Retinal fundus photograph
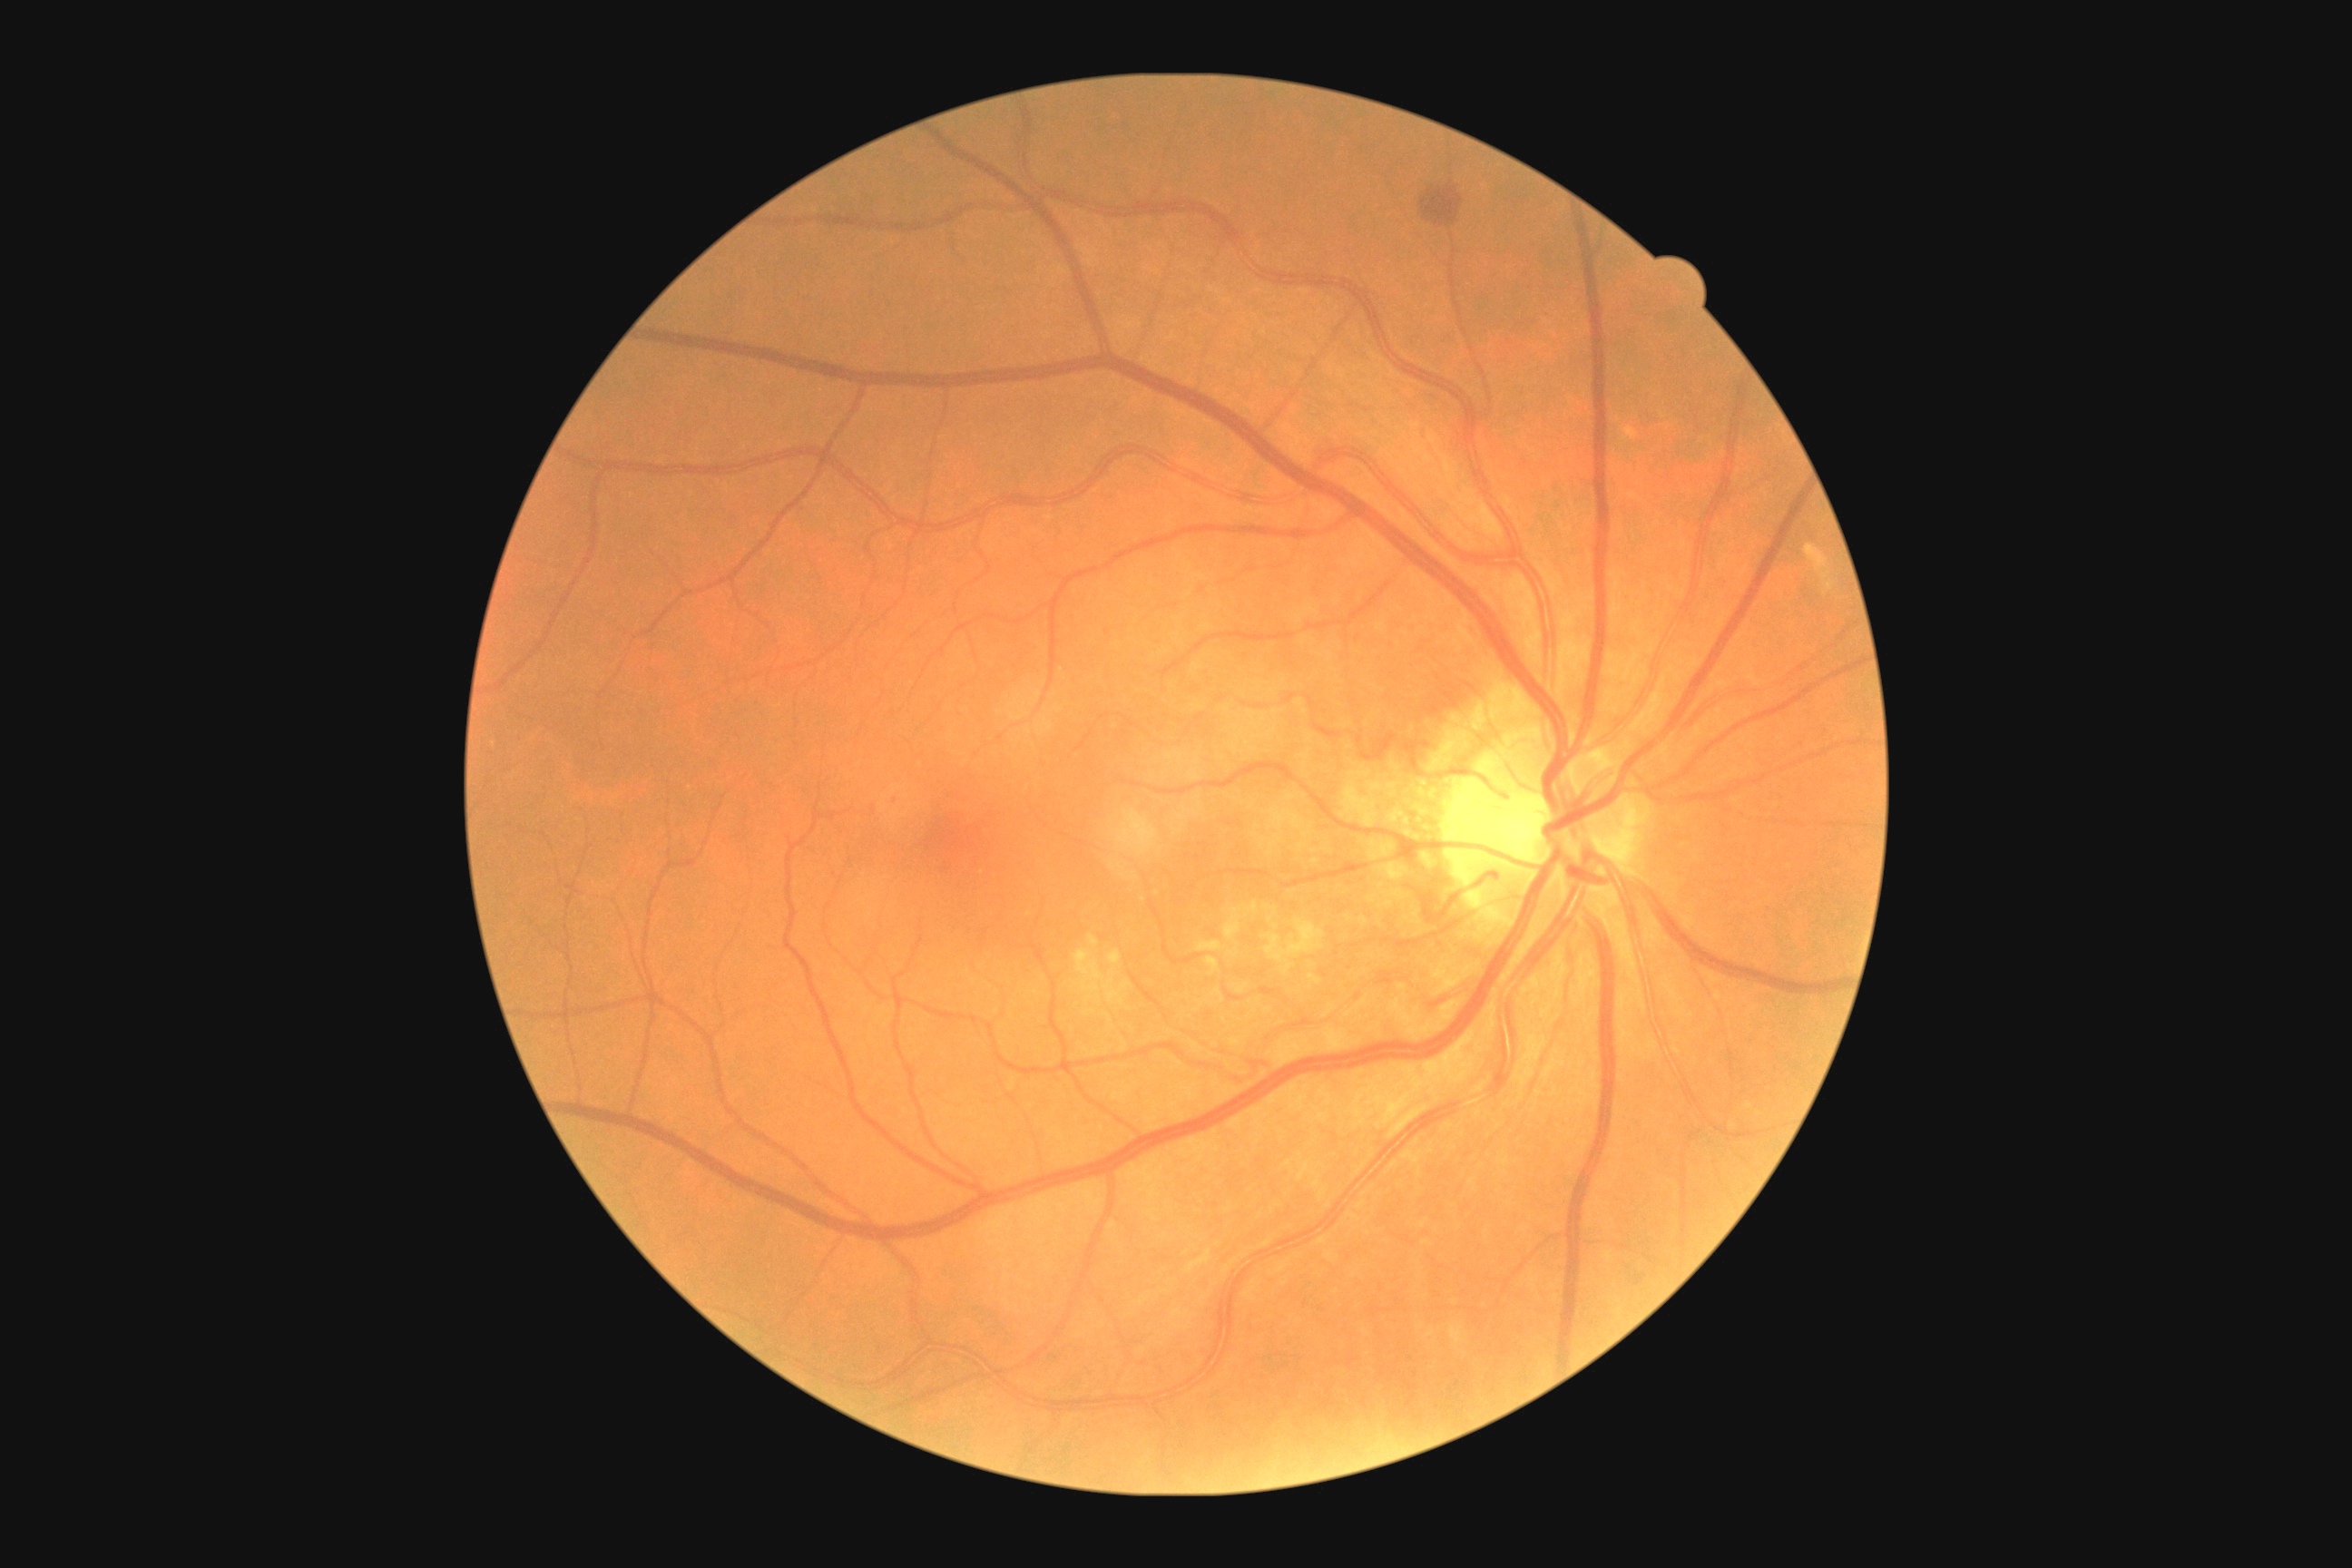 {"dr_grade": "moderate non-proliferative diabetic retinopathy (2)"}